Dilated-pupil acquisition. Field includes the optic disc and macula. Color fundus image — 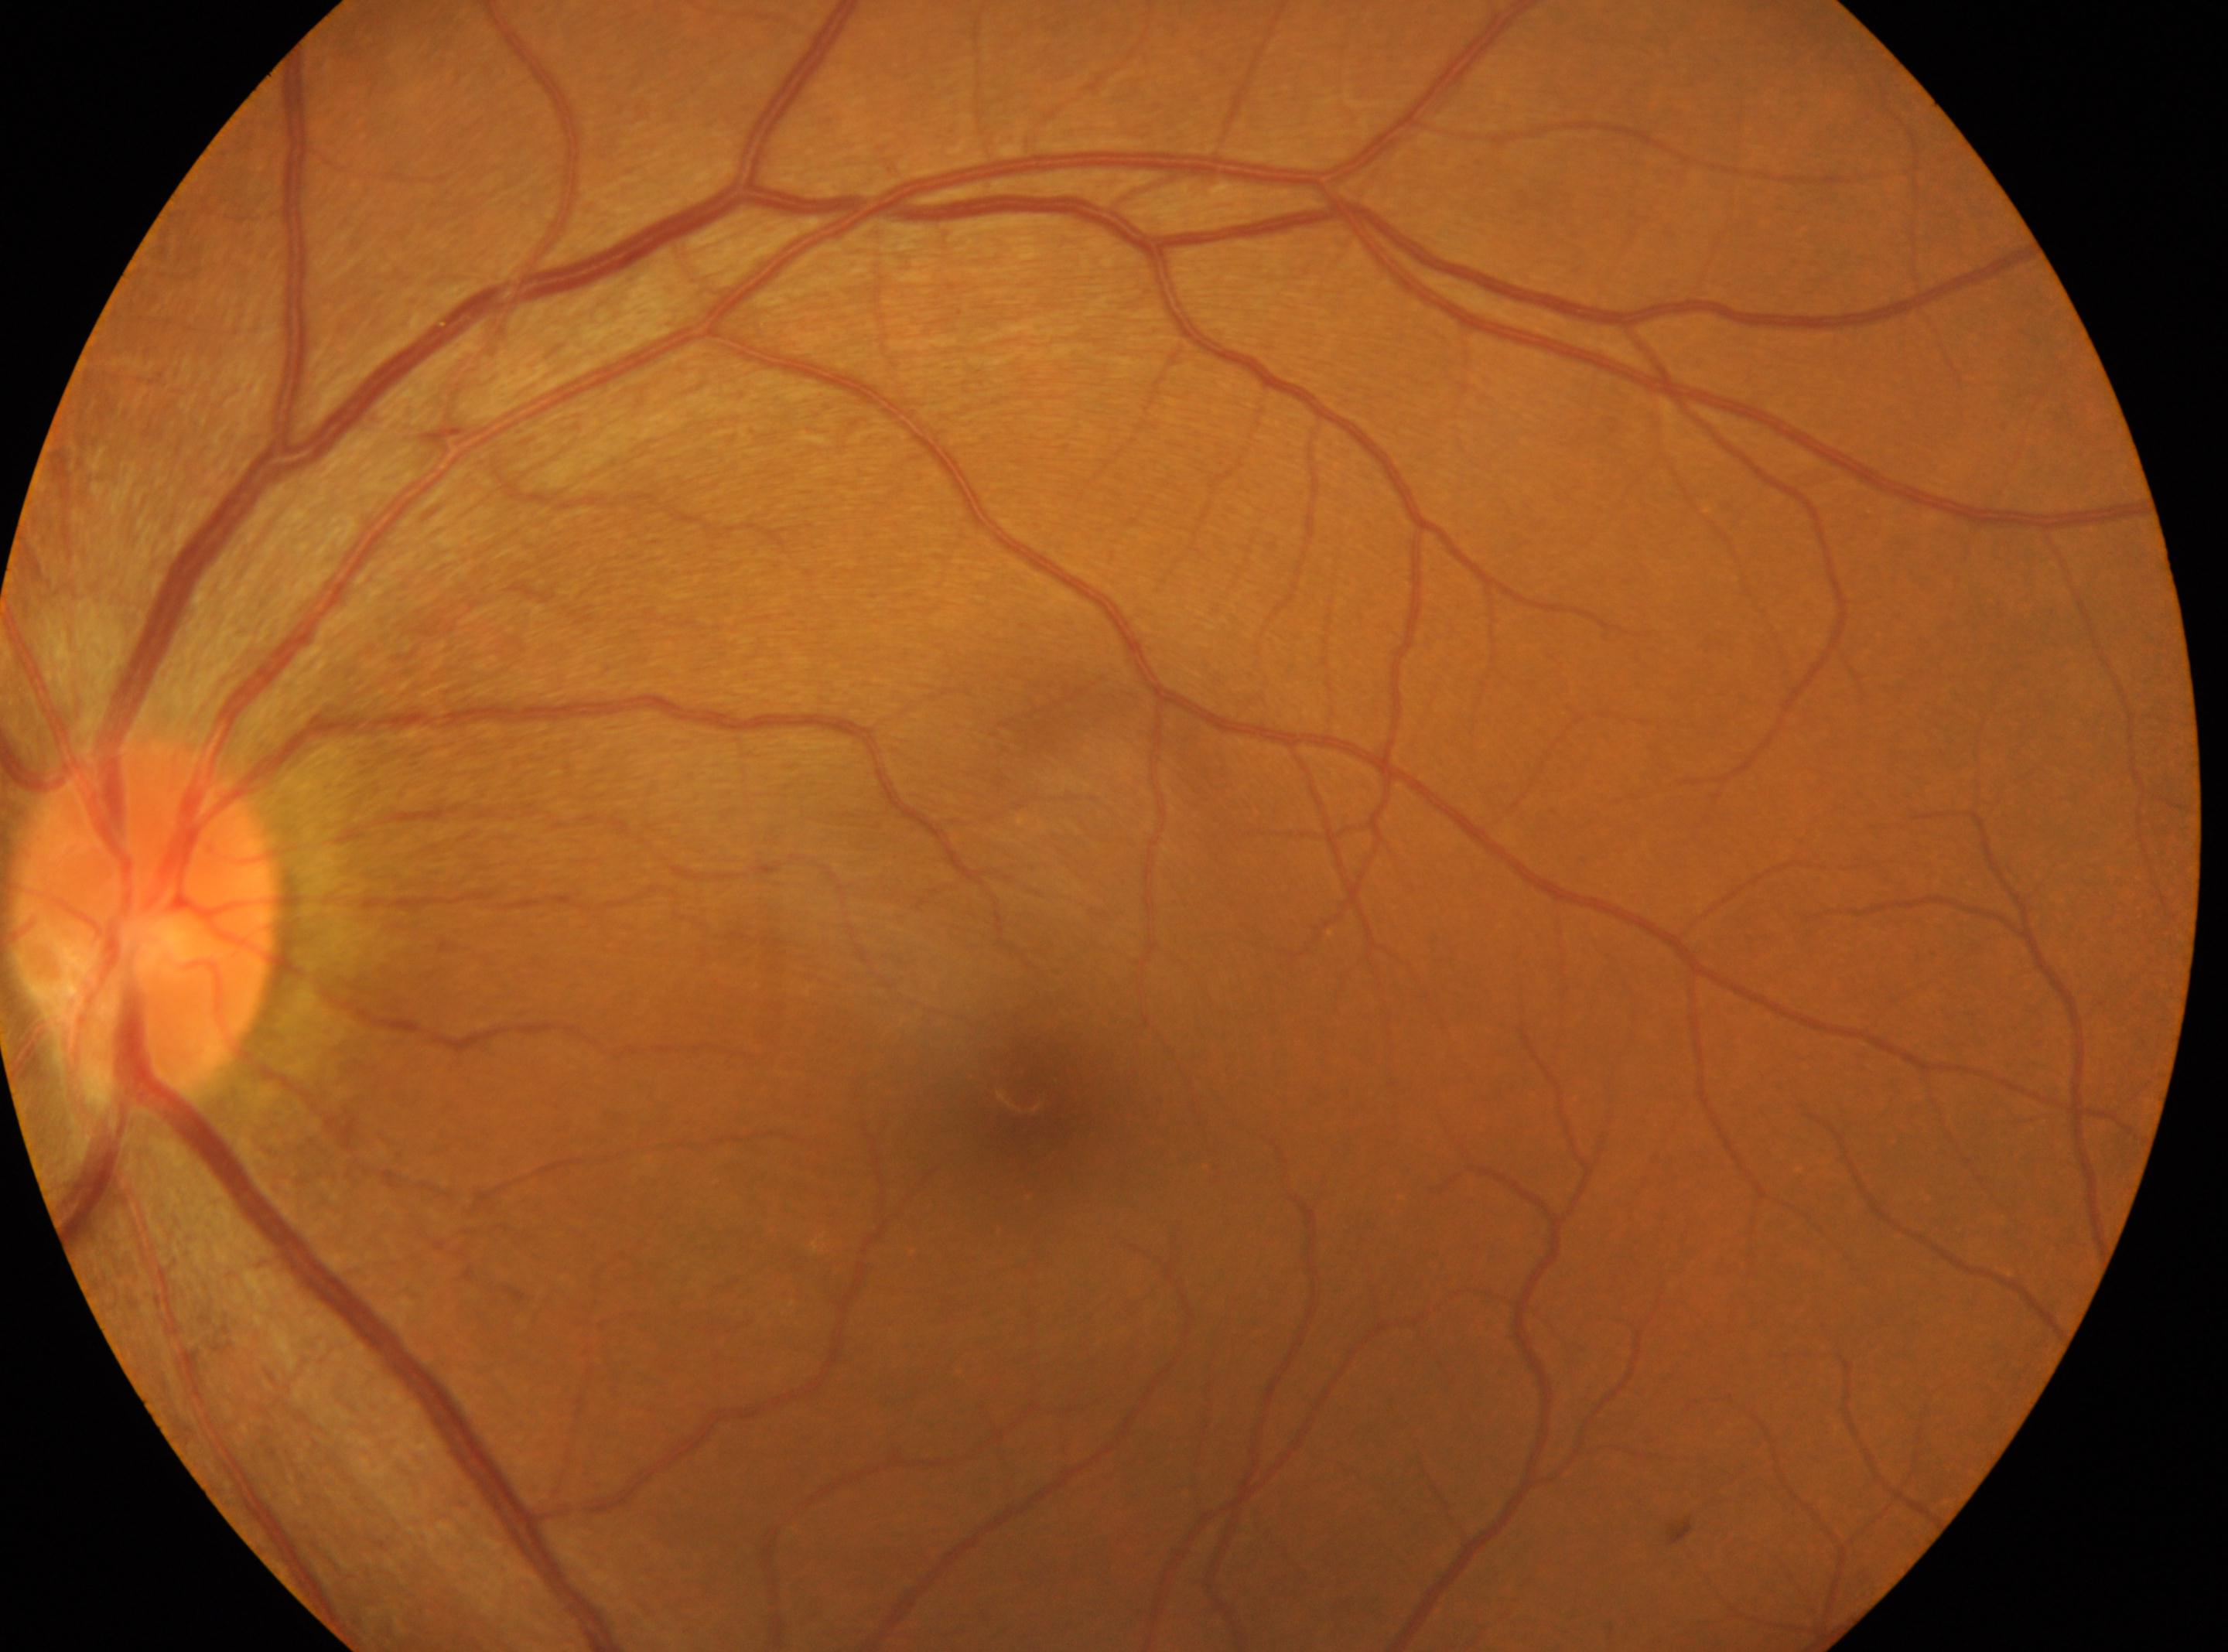

Annotations:
– DR impression: No DR findings
– the optic disc: 144px, 919px
– laterality: the left eye
– DR: grade 0 (no apparent retinopathy) — no visible signs of diabetic retinopathy
– fovea center: 1035px, 1097px